DR severity per modified Davis staging: 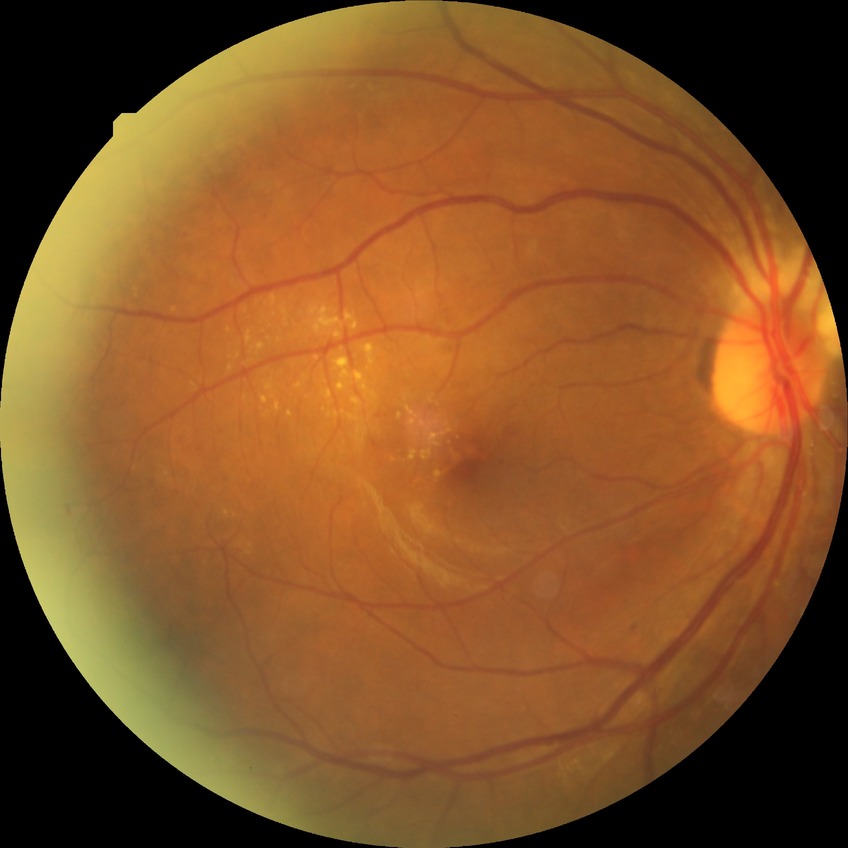

Davis stage: SDR.